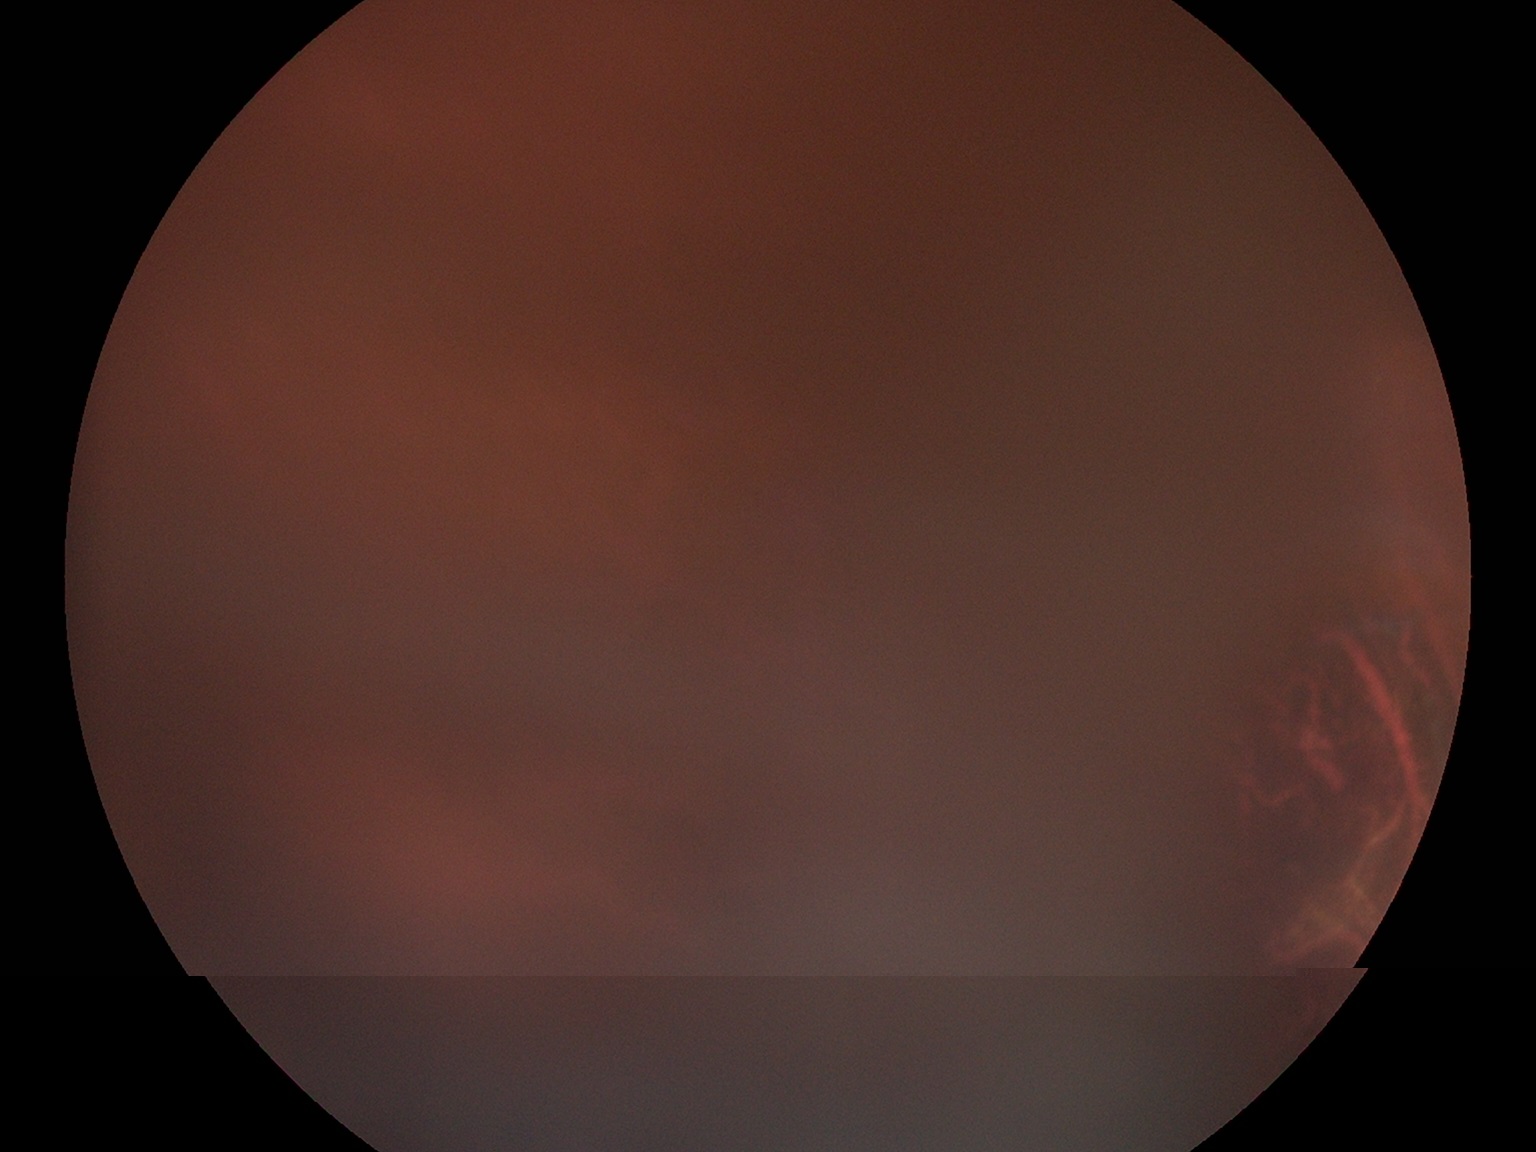

Retinopathy grade is ungradable.